1659 by 2212 pixels:
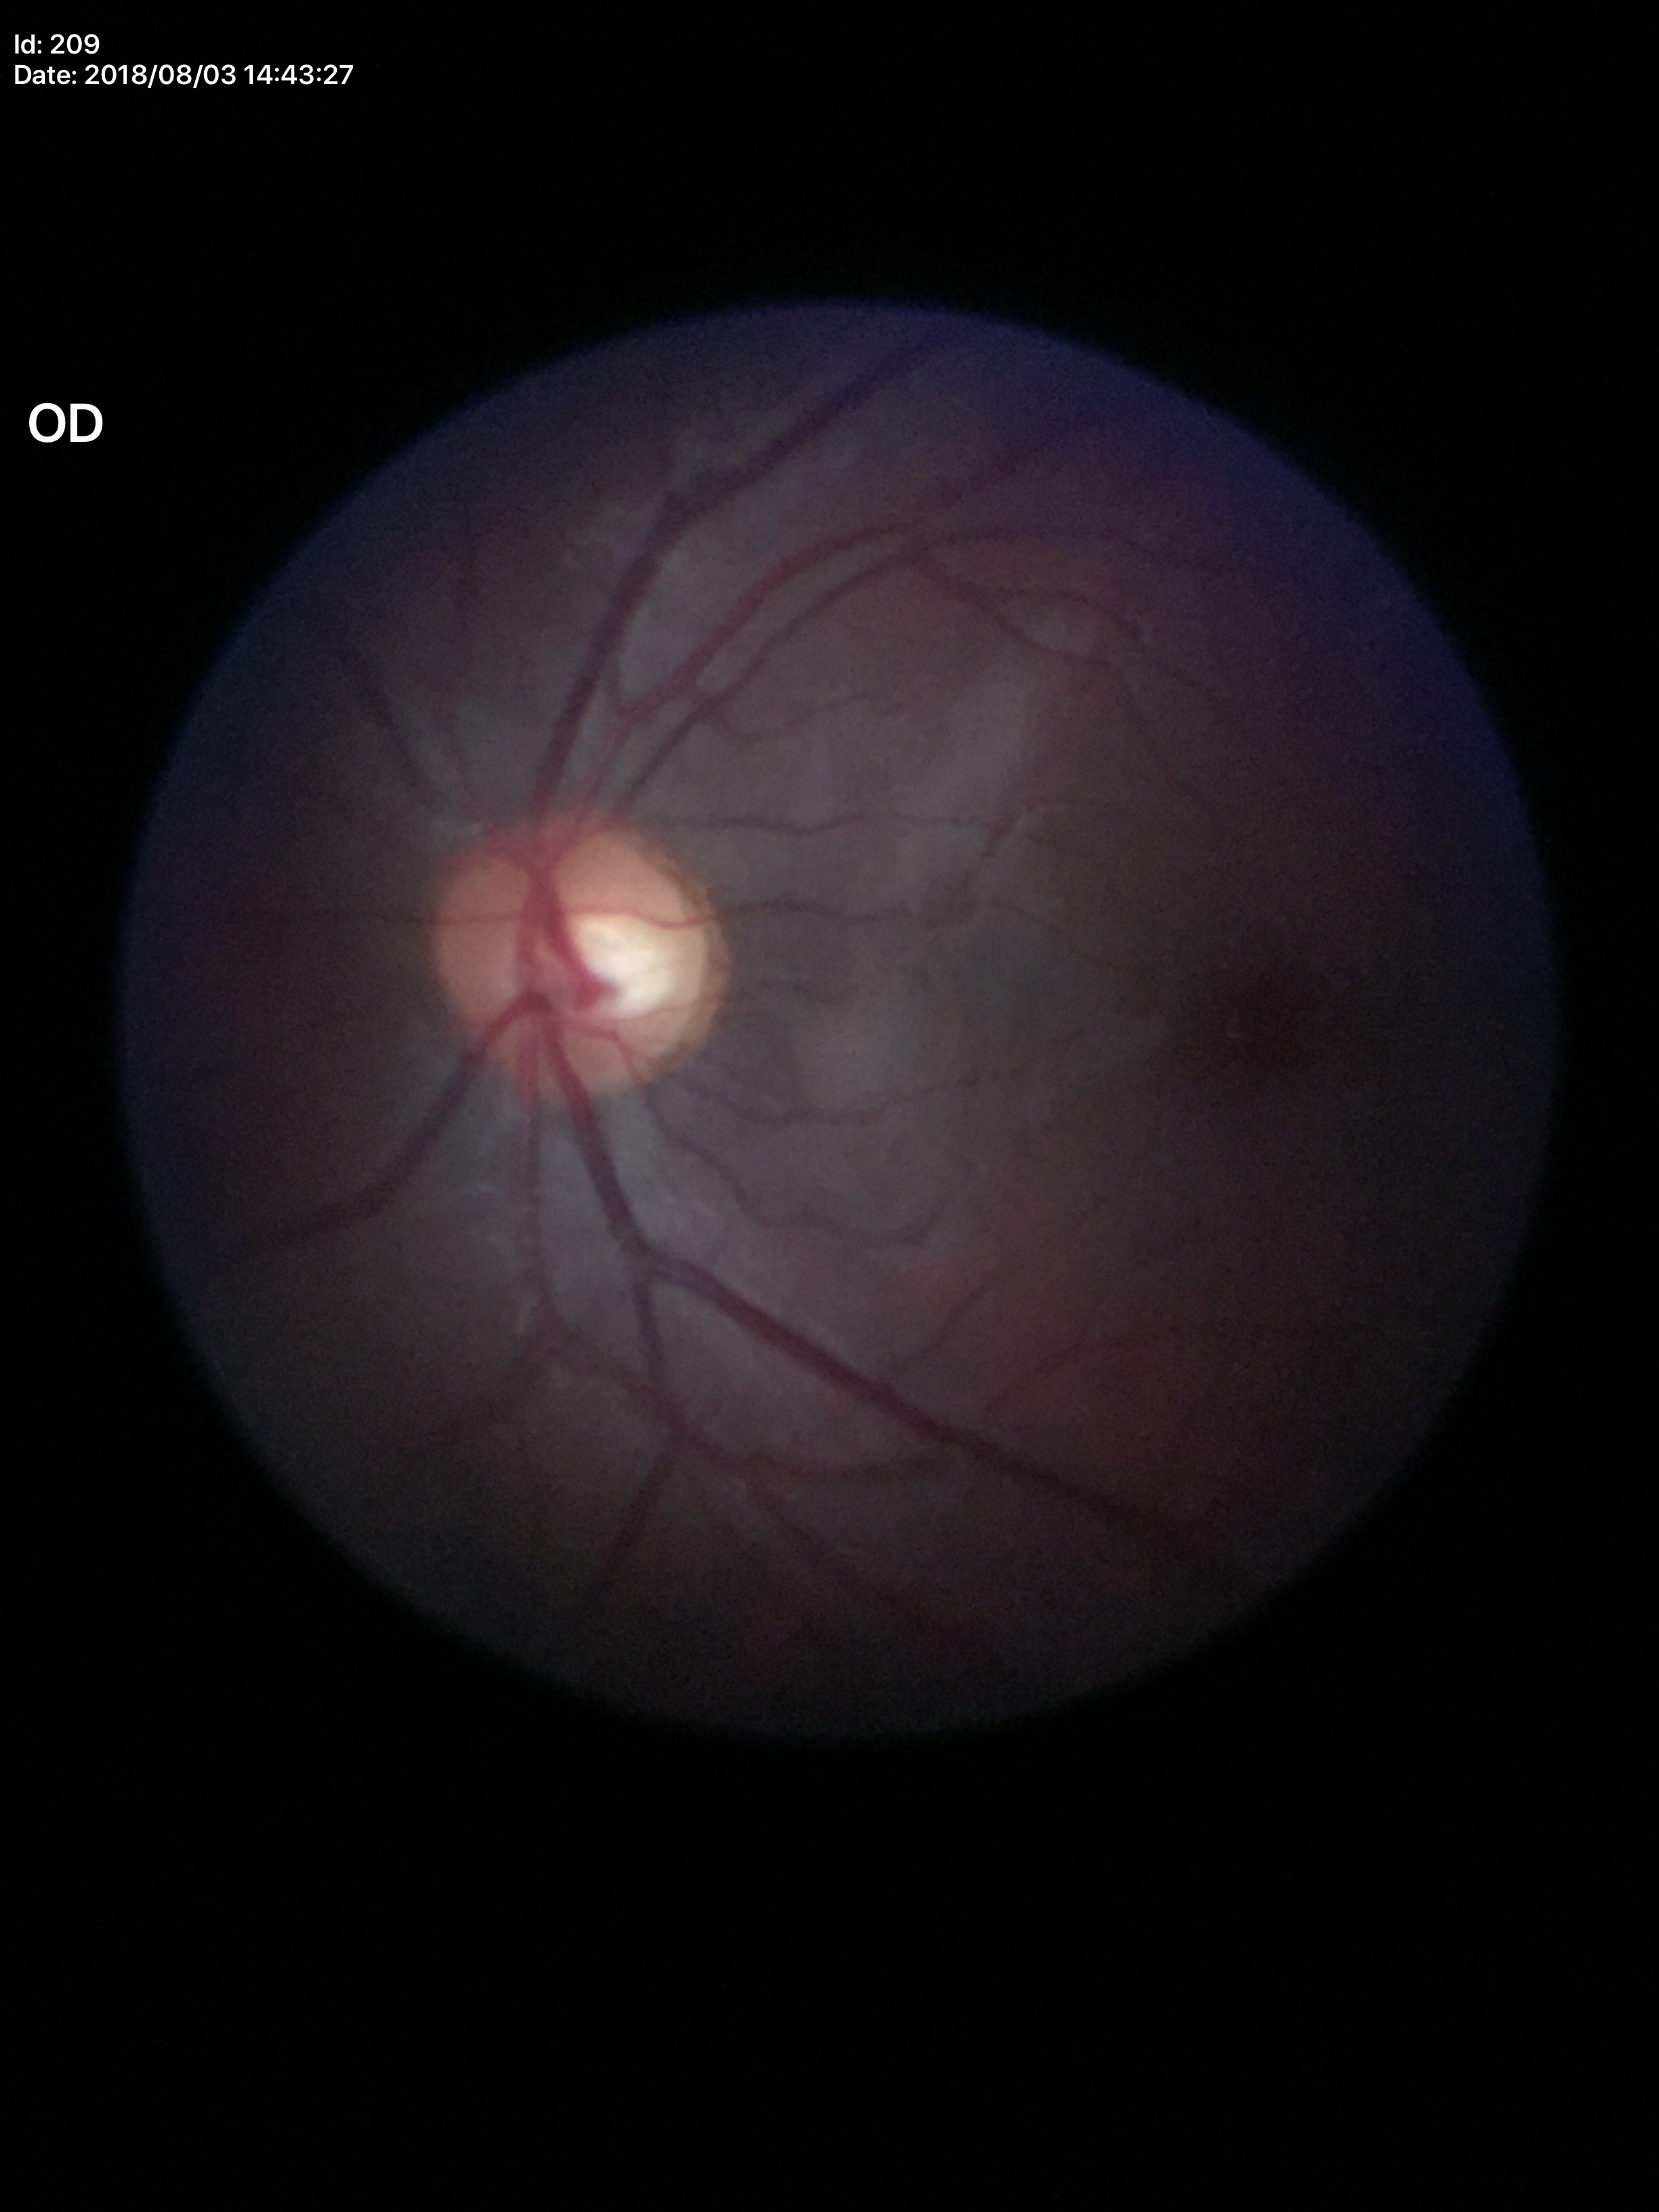
Vertical cup-disc ratio is 0.47.
Negative for glaucoma suspicion.